640x480px. Pediatric wide-field fundus photograph. Acquired on the Clarity RetCam 3 — 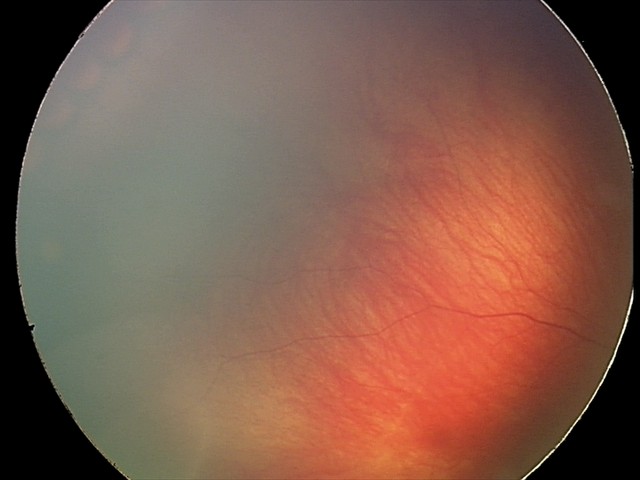
Screening series with retinal hemorrhages.